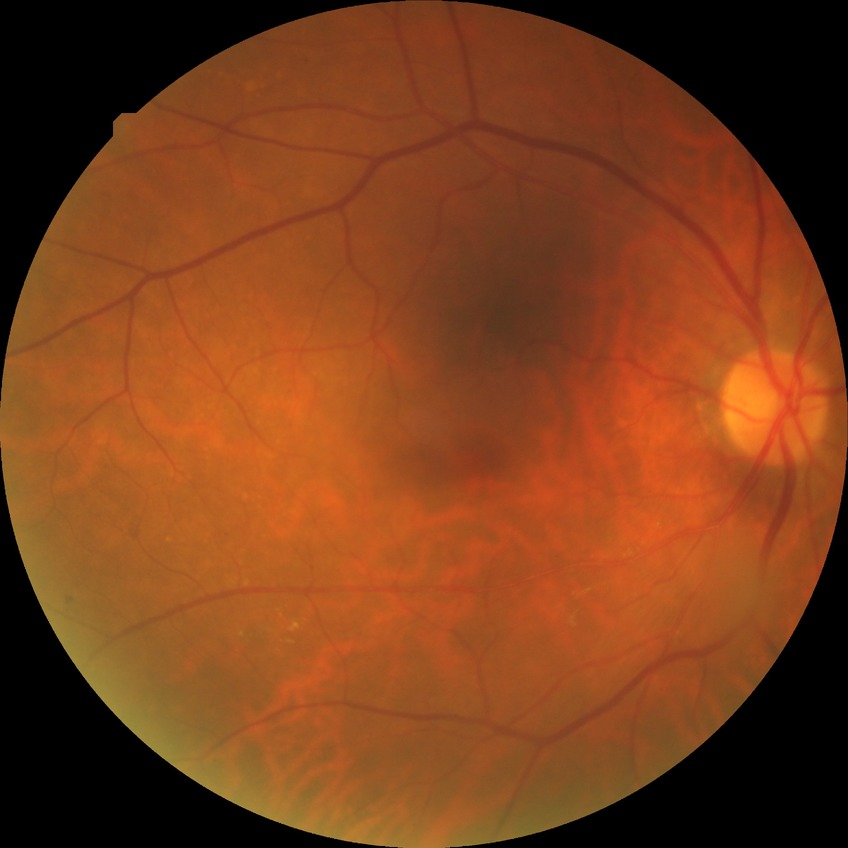 {"davis_grade": "SDR"}